Retinal fundus photograph · FOV: 45 degrees:
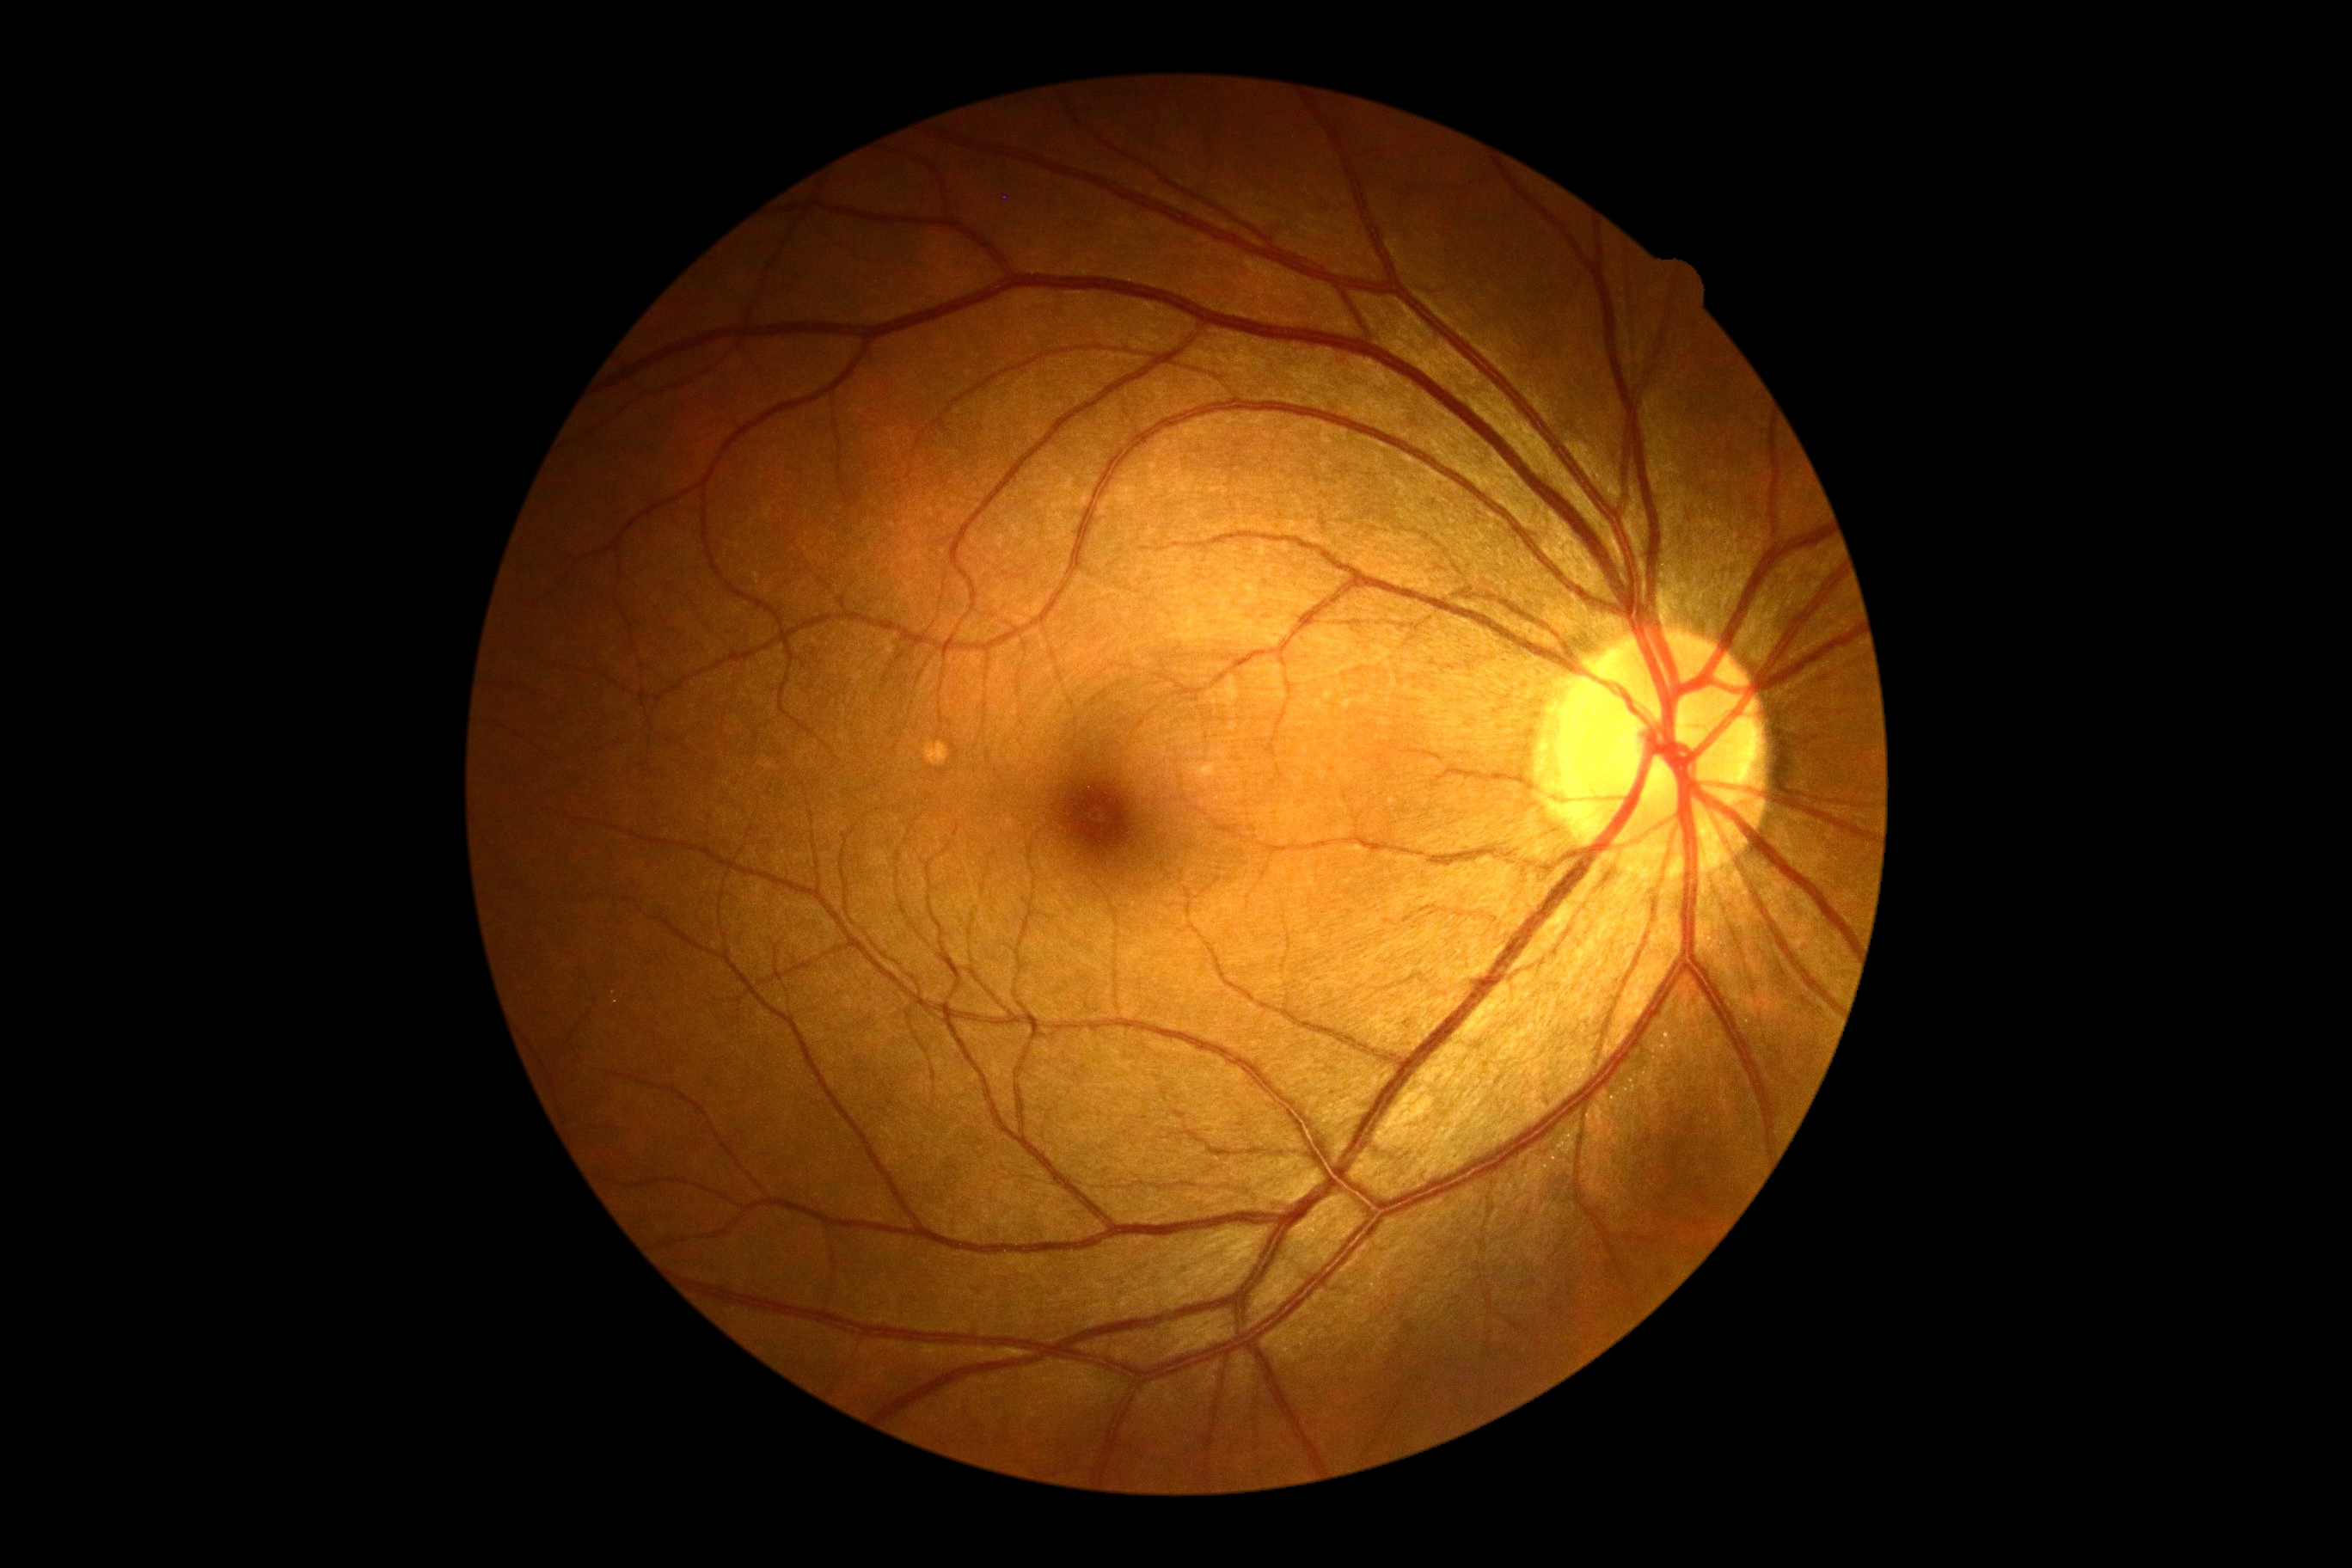

* DR — no apparent diabetic retinopathy (grade 0)